100° field of view (Phoenix ICON). Wide-field contact fundus photograph of an infant. 1240 x 1240 pixels — 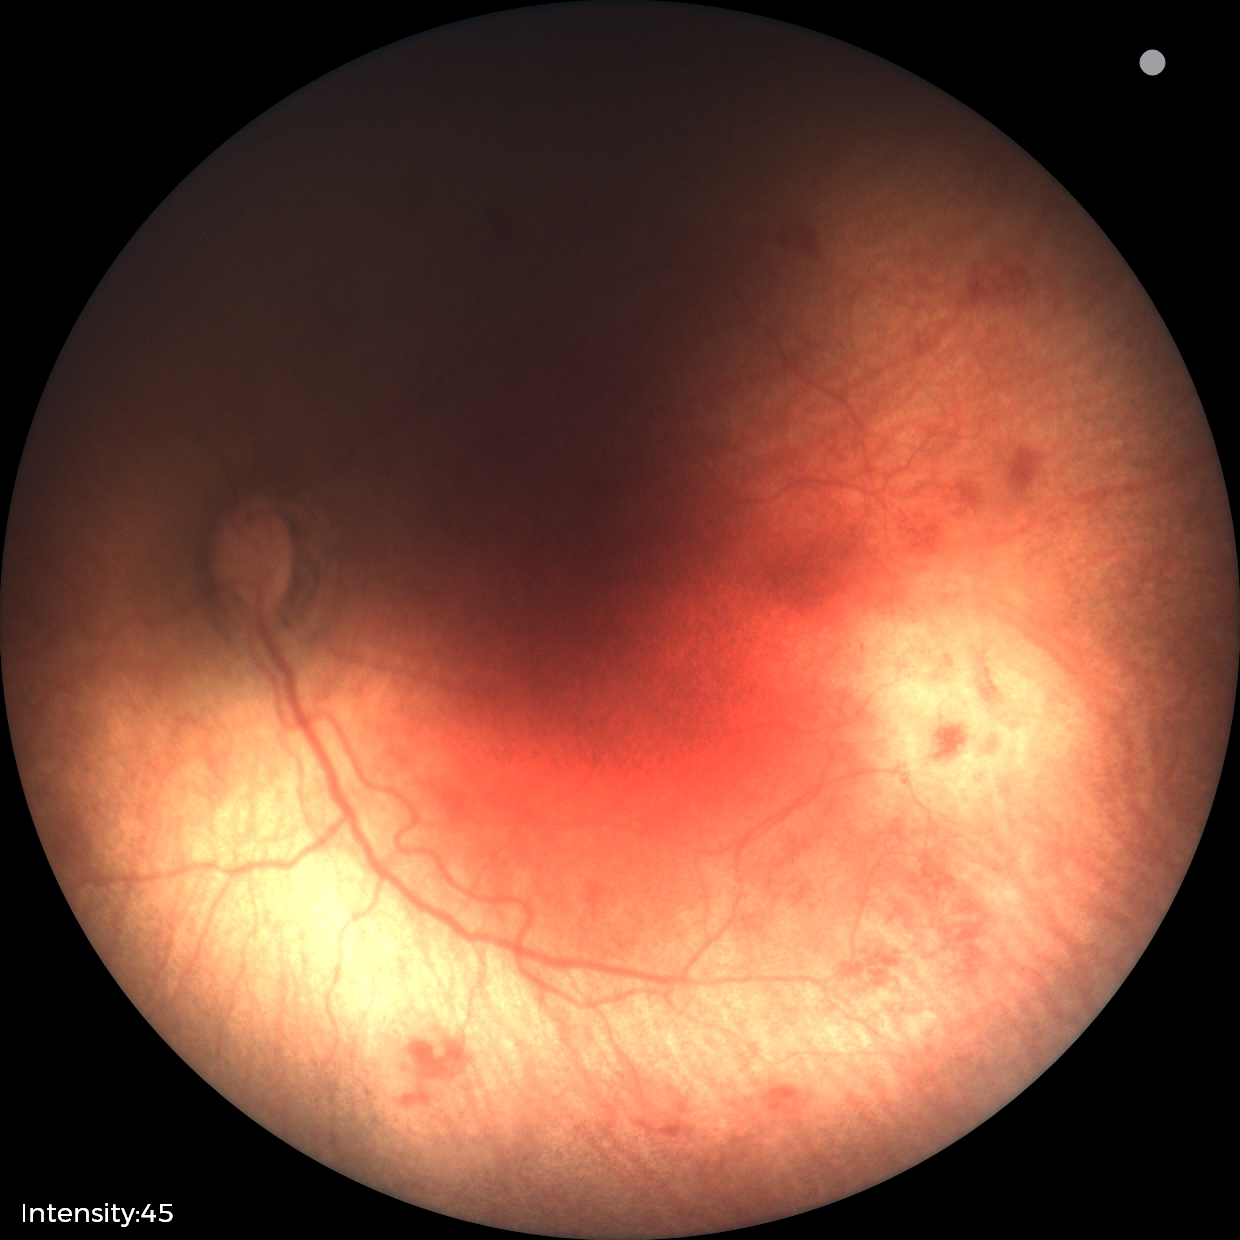

Examination diagnosed as retinopathy of prematurity (ROP) stage 1. No plus disease.